2048x1536; retinal fundus photograph:
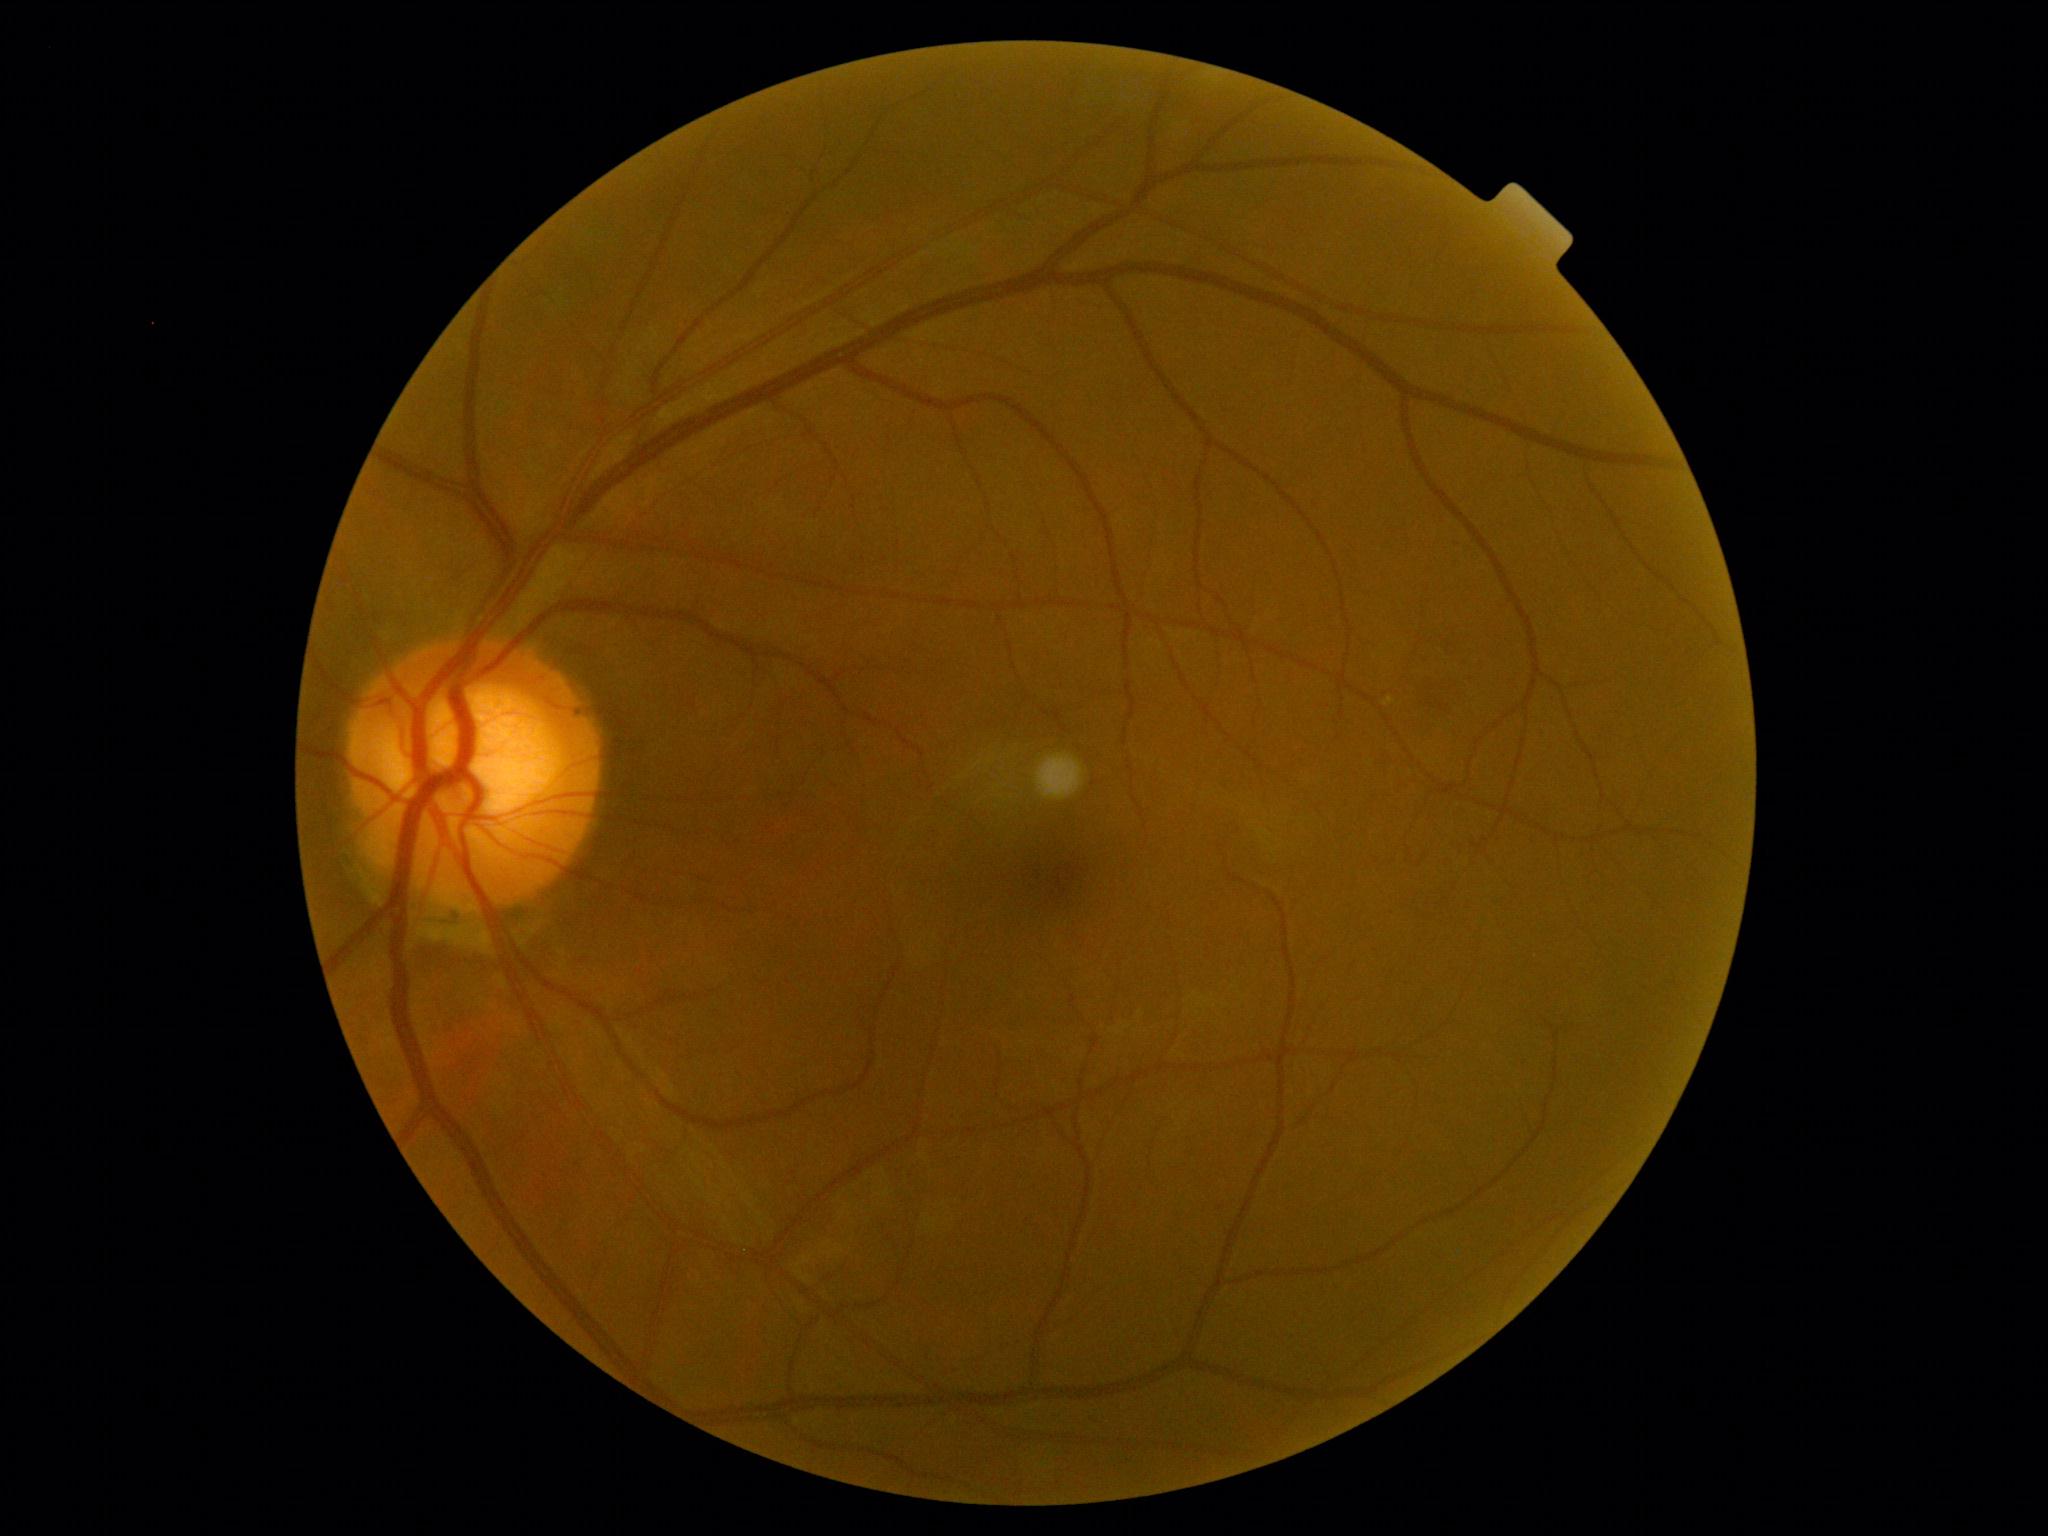 diabetic retinopathy (DR)@grade 0, DR impression@negative for DR.